1380 by 1382 pixels:
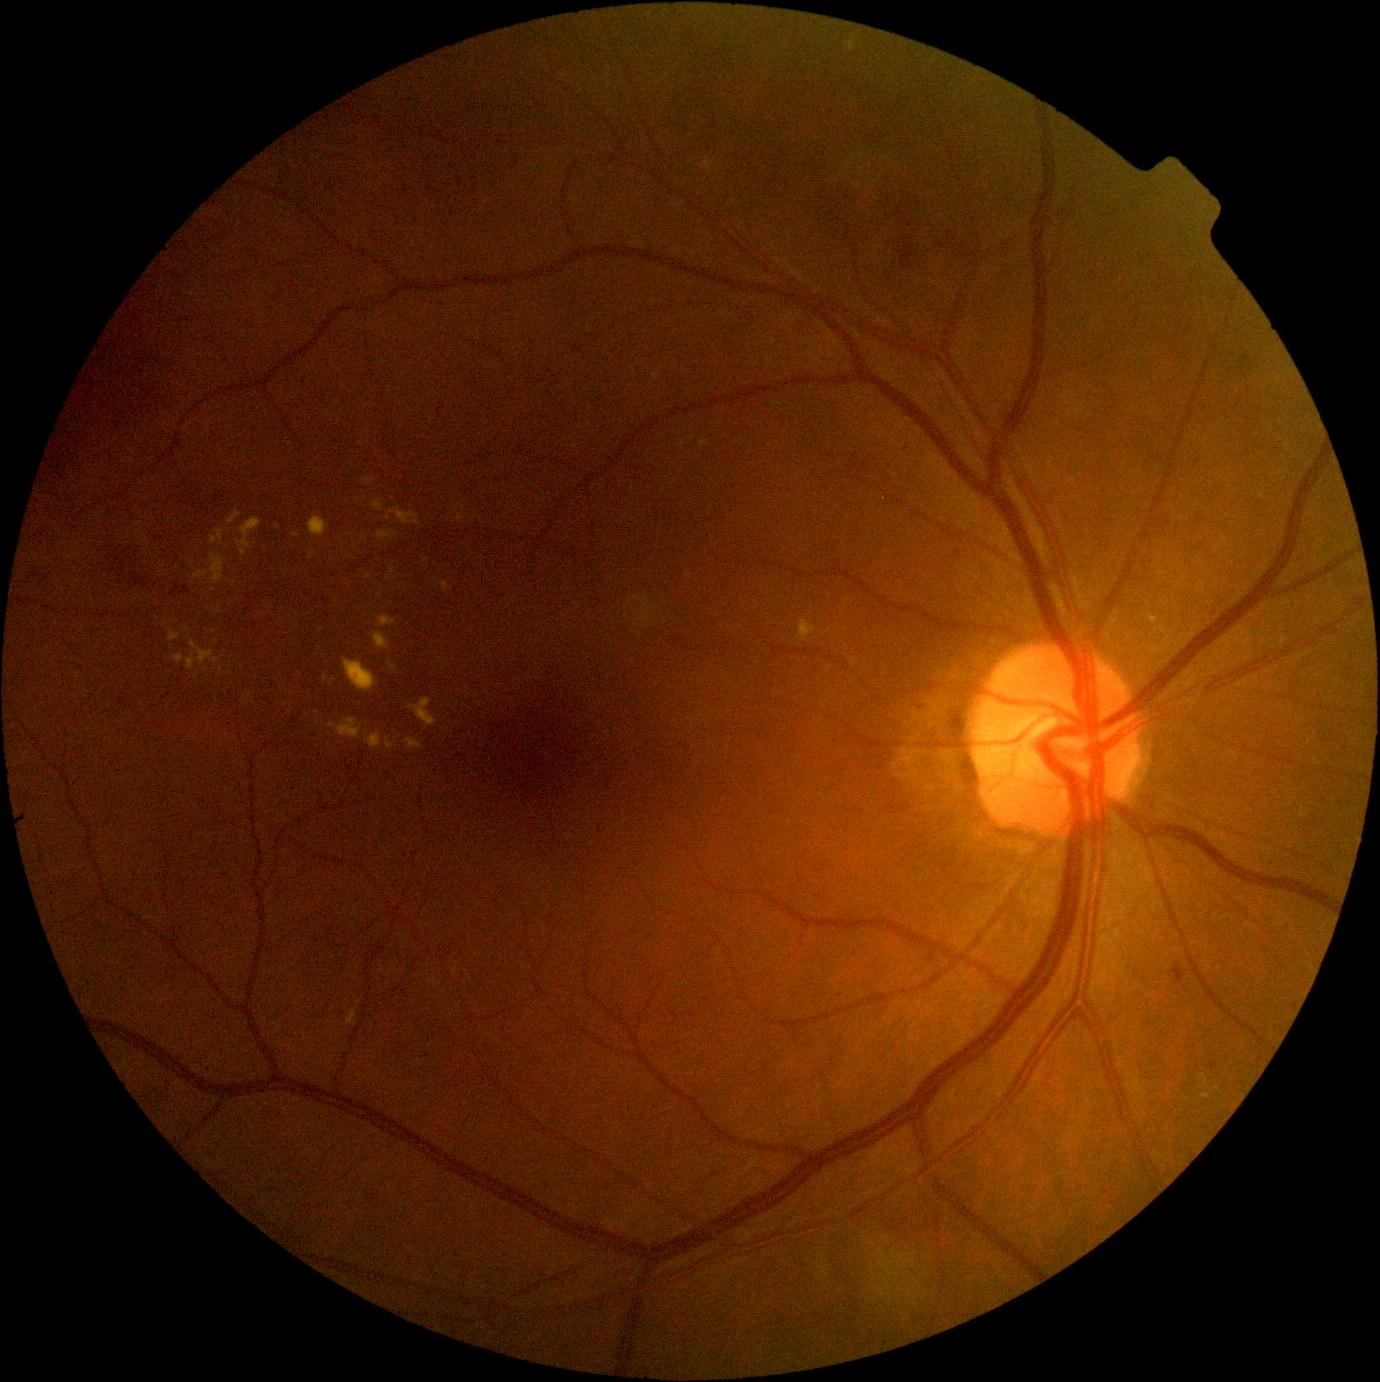

diabetic retinopathy (DR)=grade 2.